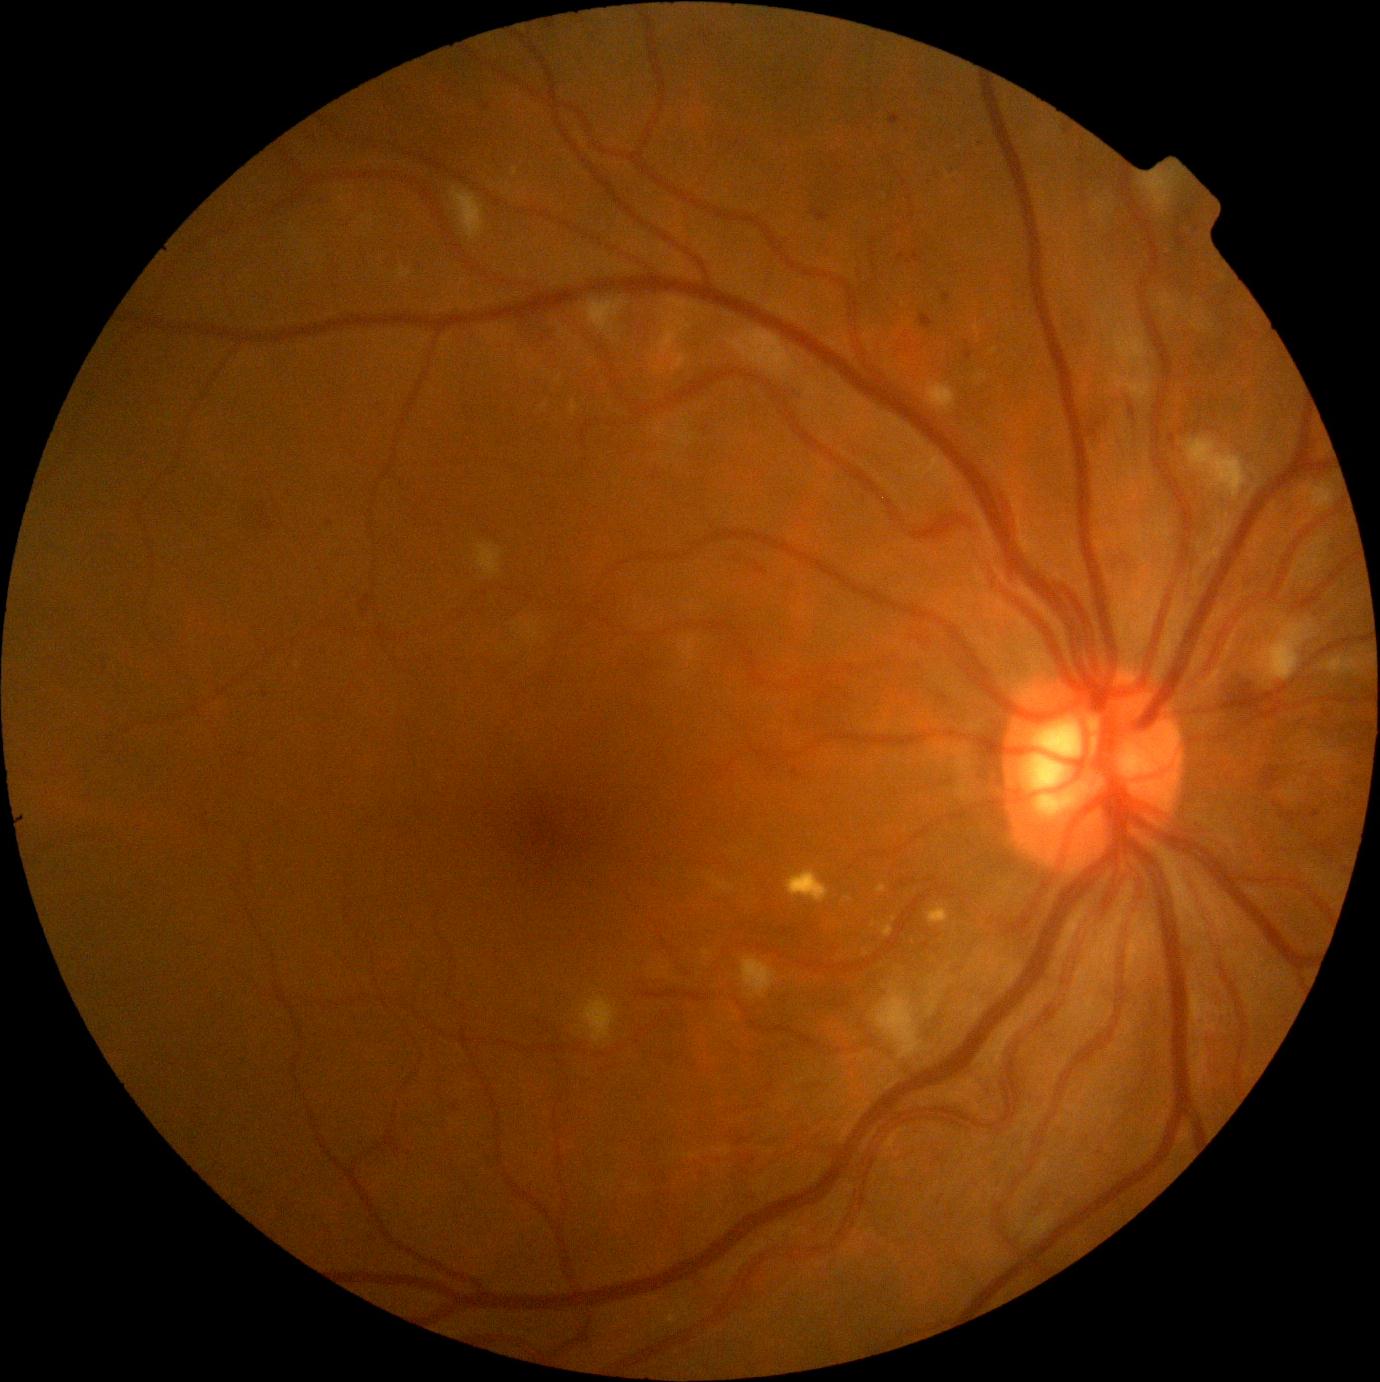
Diabetic retinopathy grade is 2 (moderate NPDR)
Selected lesions:
* microaneurysms (subset): (919, 314, 934, 329) | (1176, 238, 1187, 247) | (1178, 227, 1182, 235) | (1184, 209, 1195, 221) | (943, 294, 951, 302) | (1311, 810, 1320, 818) | (1063, 124, 1073, 135)
* Microaneurysms (small, approximate centers) near (487,107) | (910,262) | (1197,229) | (330,524)